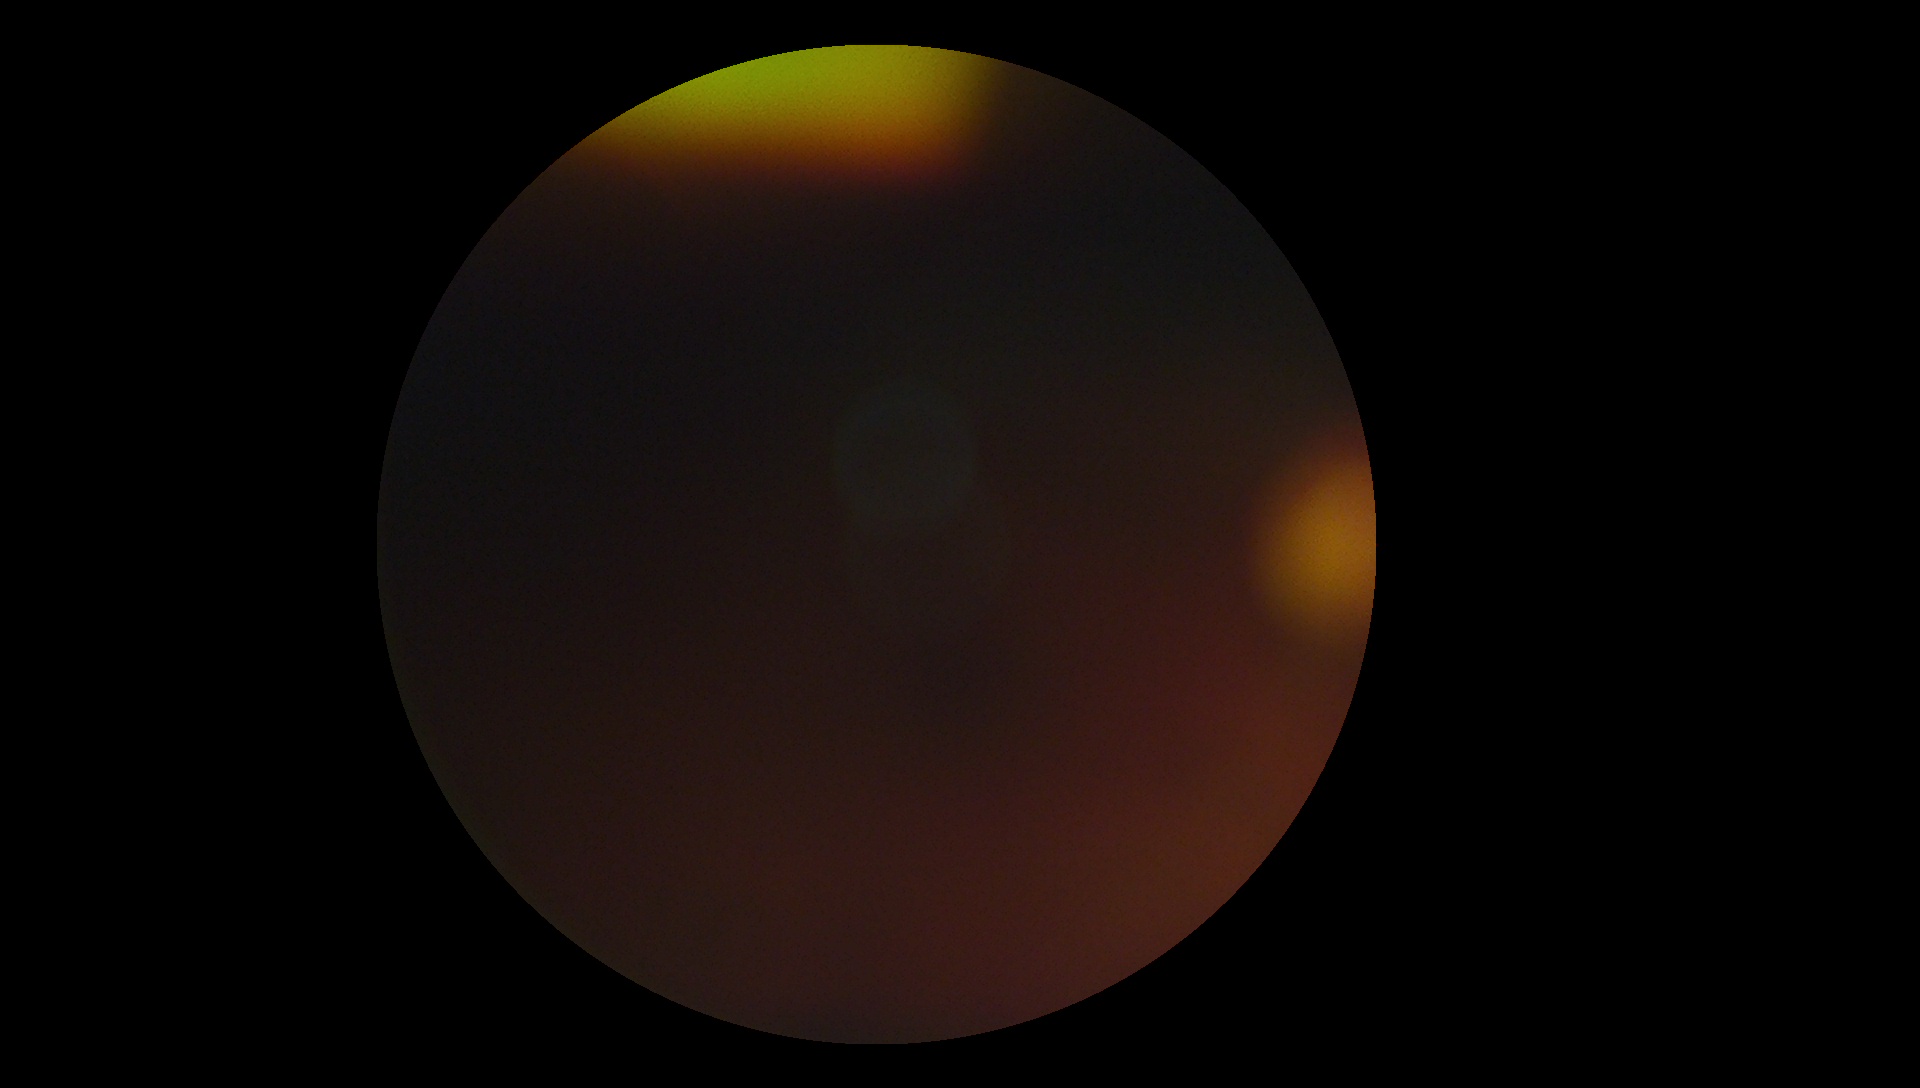
Findings:
* diabetic retinopathy — ungradable